Wide-field fundus image from infant ROP screening:
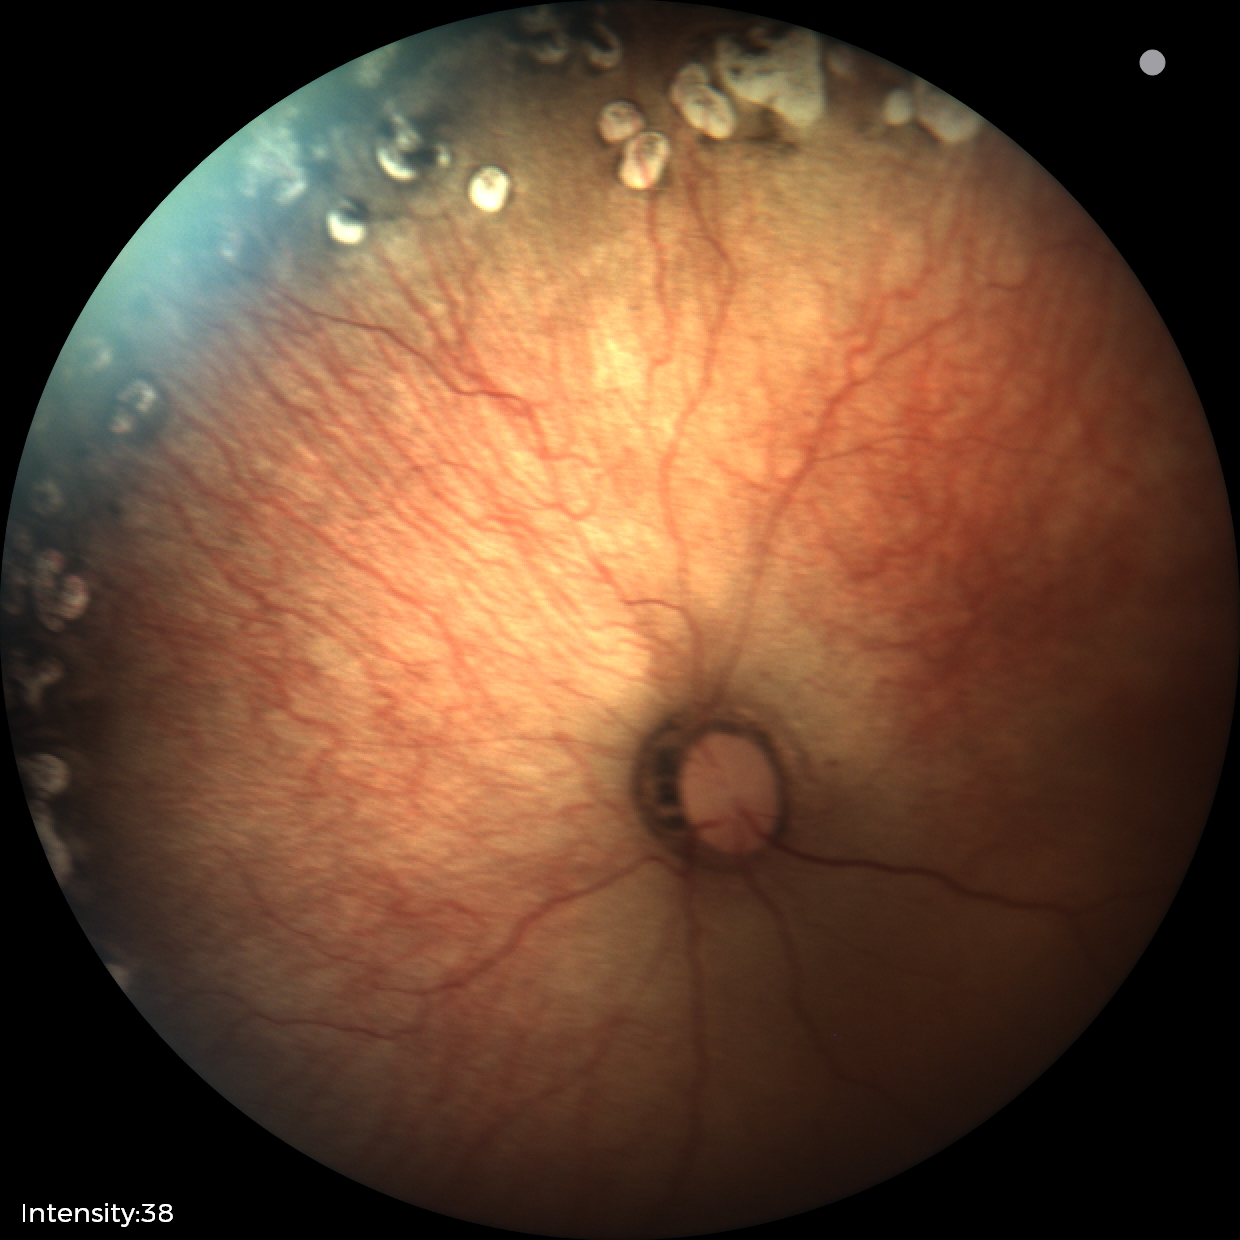
Diagnosis: status post ROP.